Pediatric retinal photograph (wide-field) — 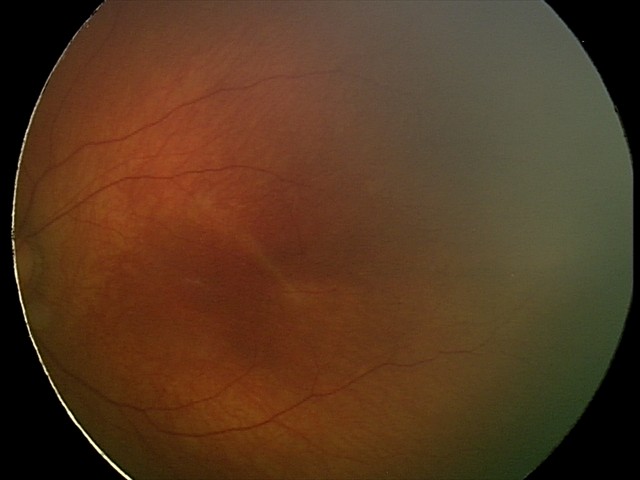
Screening examination with no abnormal retinal findings.